2212 x 1659 pixels — 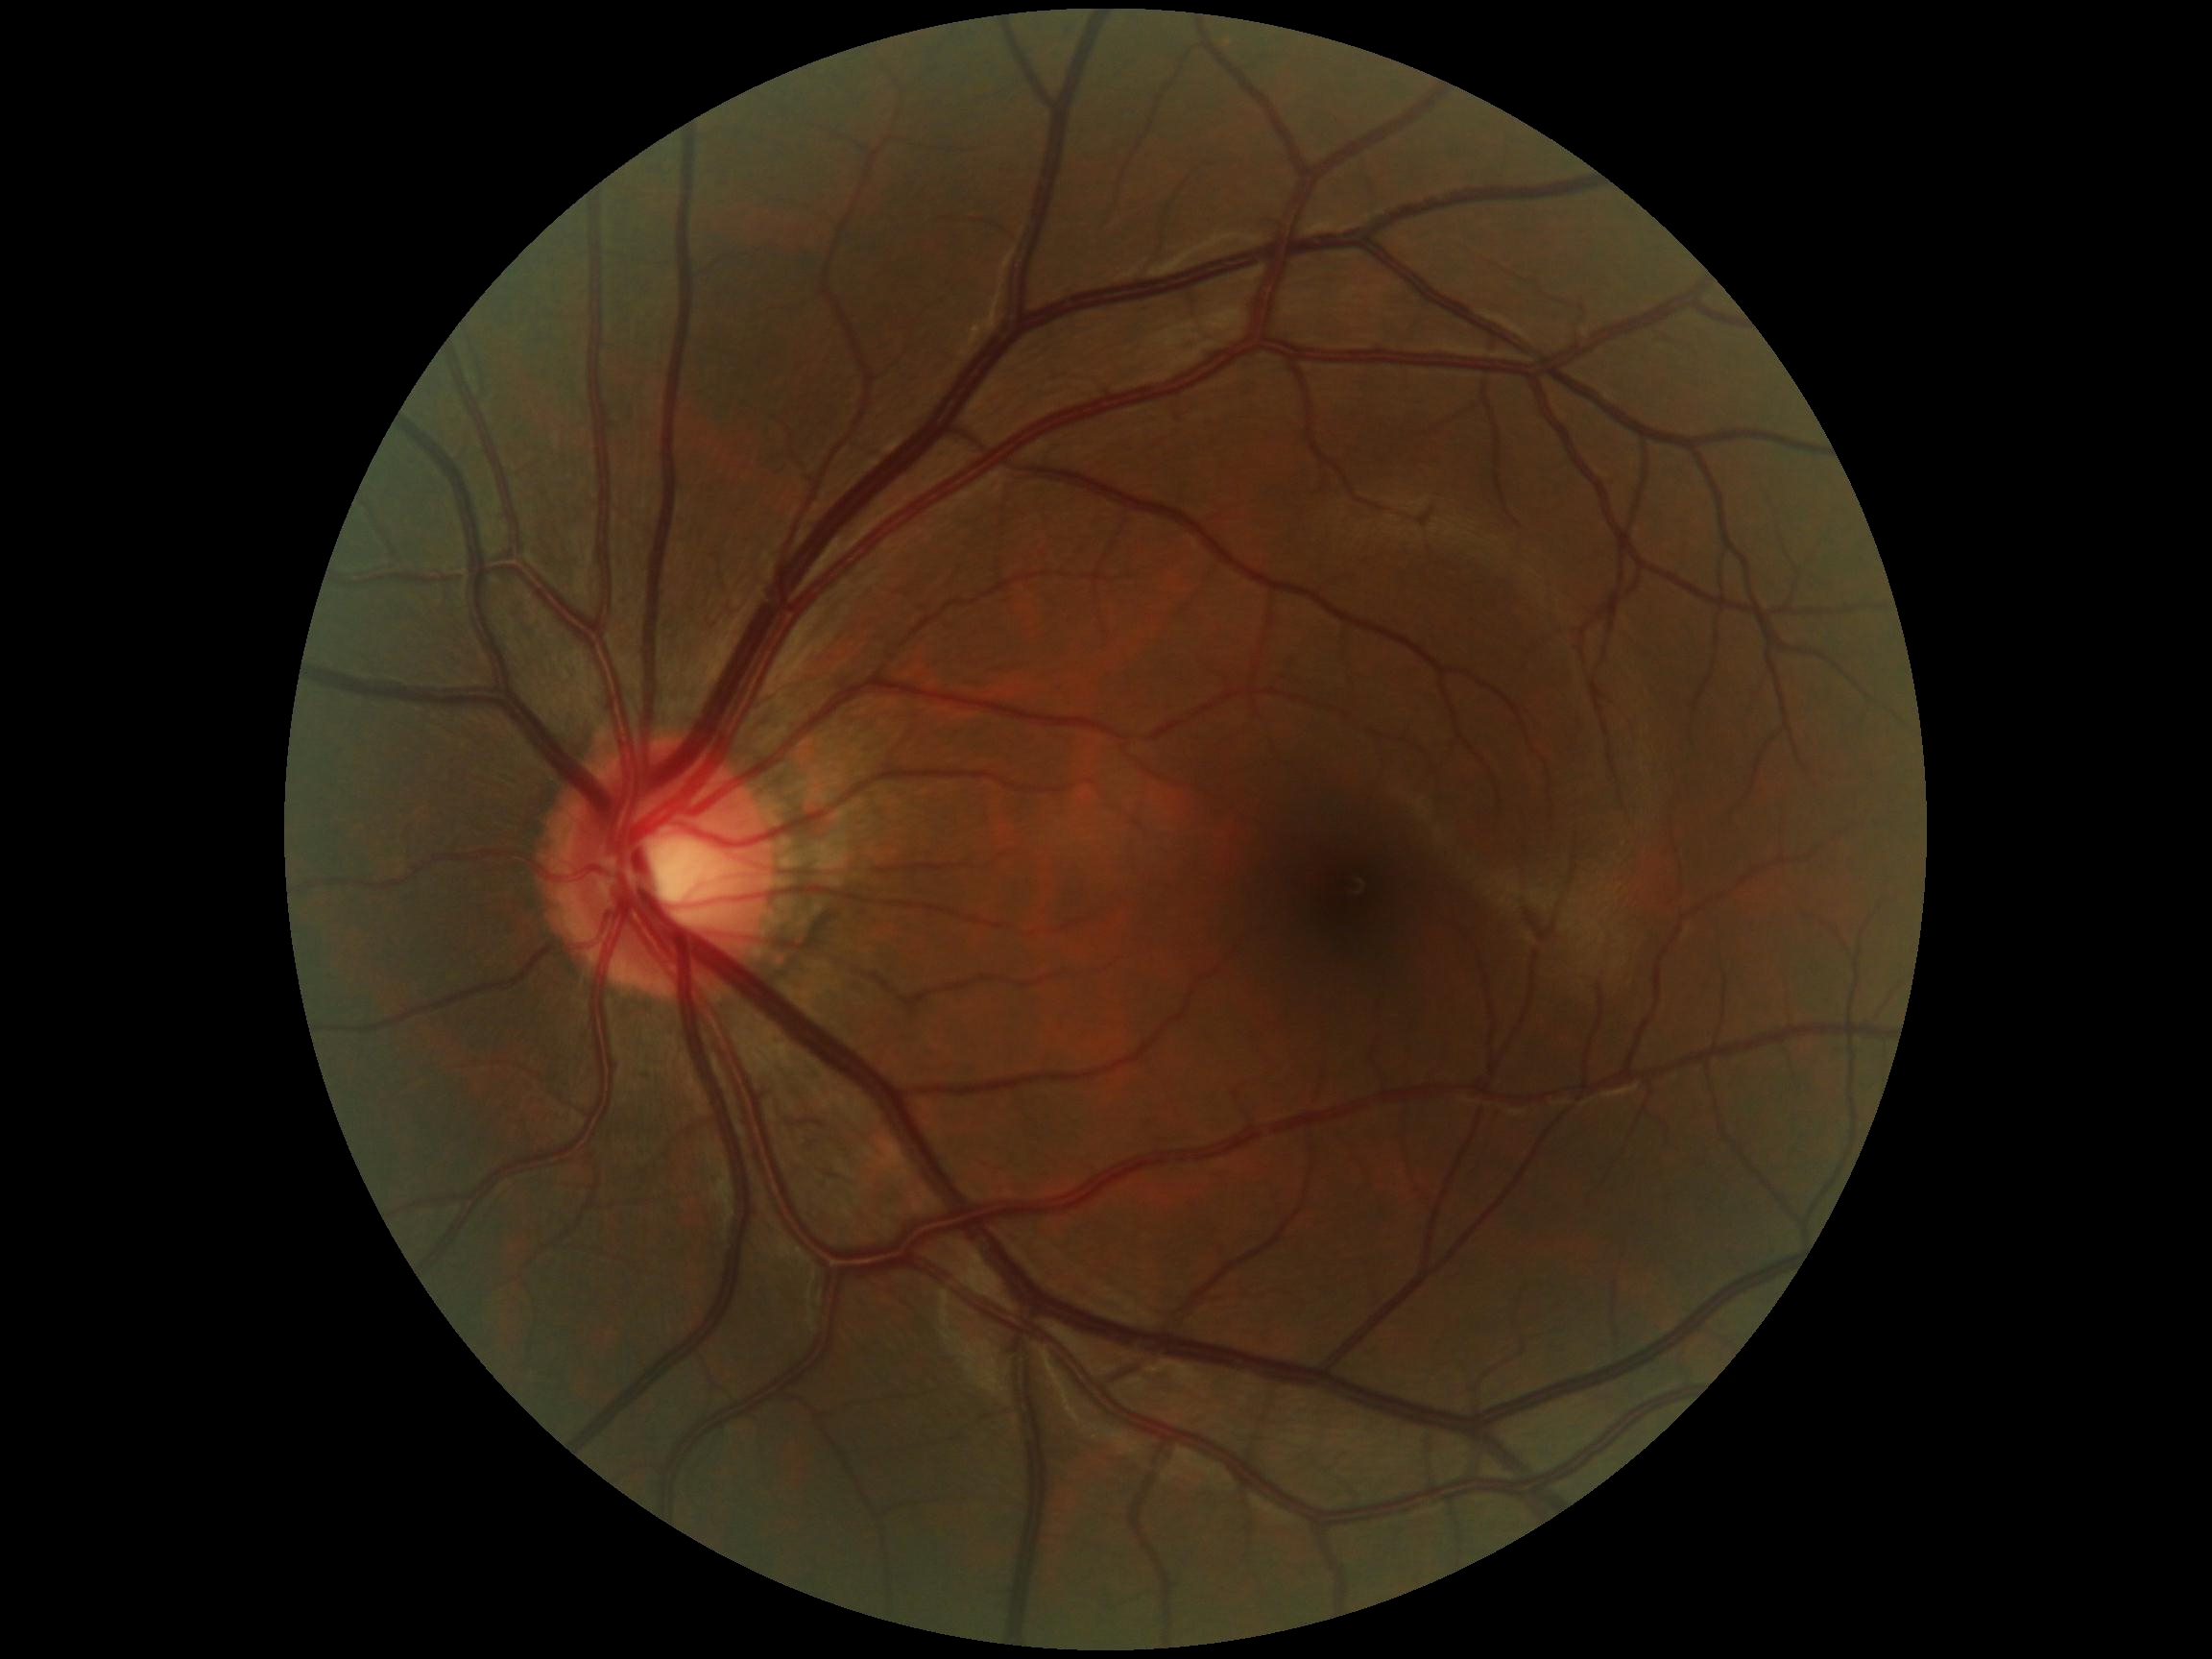
No signs of diabetic retinopathy. Diabetic retinopathy (DR): grade 0 (no apparent retinopathy).